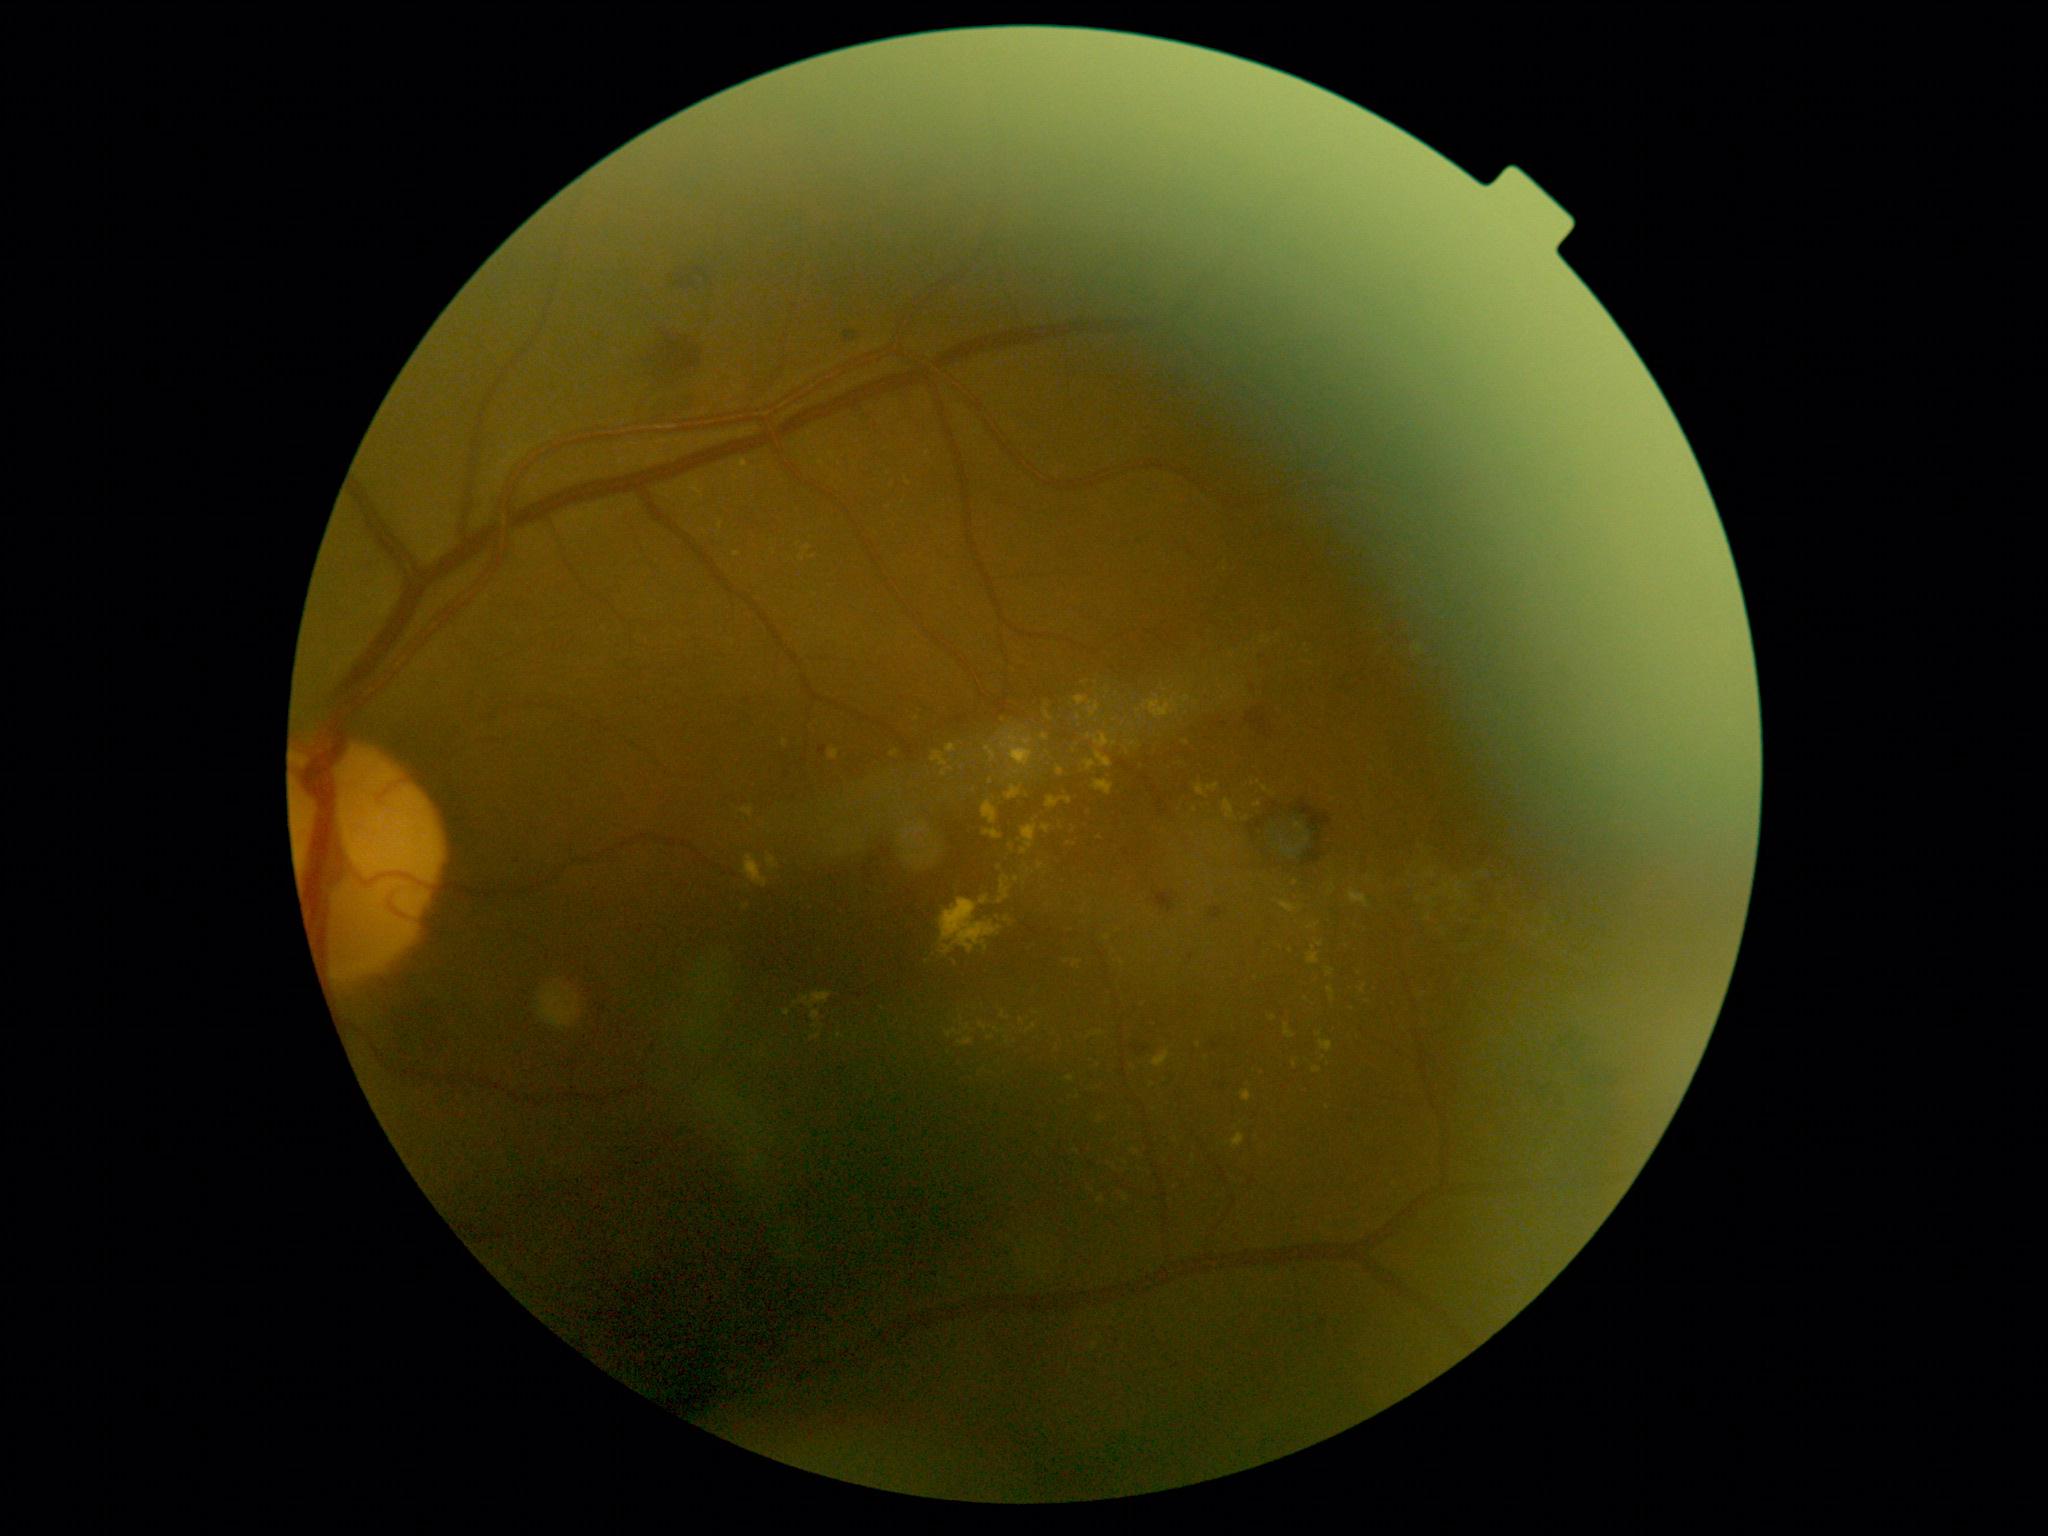

Retinopathy grade: moderate non-proliferative diabetic retinopathy (2)
Selected lesions:
- hard exudates (partial): region(1294, 823, 1305, 832) | region(1455, 882, 1464, 903) | region(998, 877, 1012, 904) | region(1241, 1091, 1252, 1103) | region(890, 751, 899, 758) | region(905, 846, 942, 872) | region(1445, 882, 1452, 894) | region(1005, 785, 1022, 801)
- Small hard exudates near x=908, y=483 | x=962, y=1019 | x=1107, y=939 | x=786, y=1013 | x=808, y=548 | x=930, y=836 | x=991, y=782 | x=1259, y=783 | x=1291, y=951 | x=1452, y=899